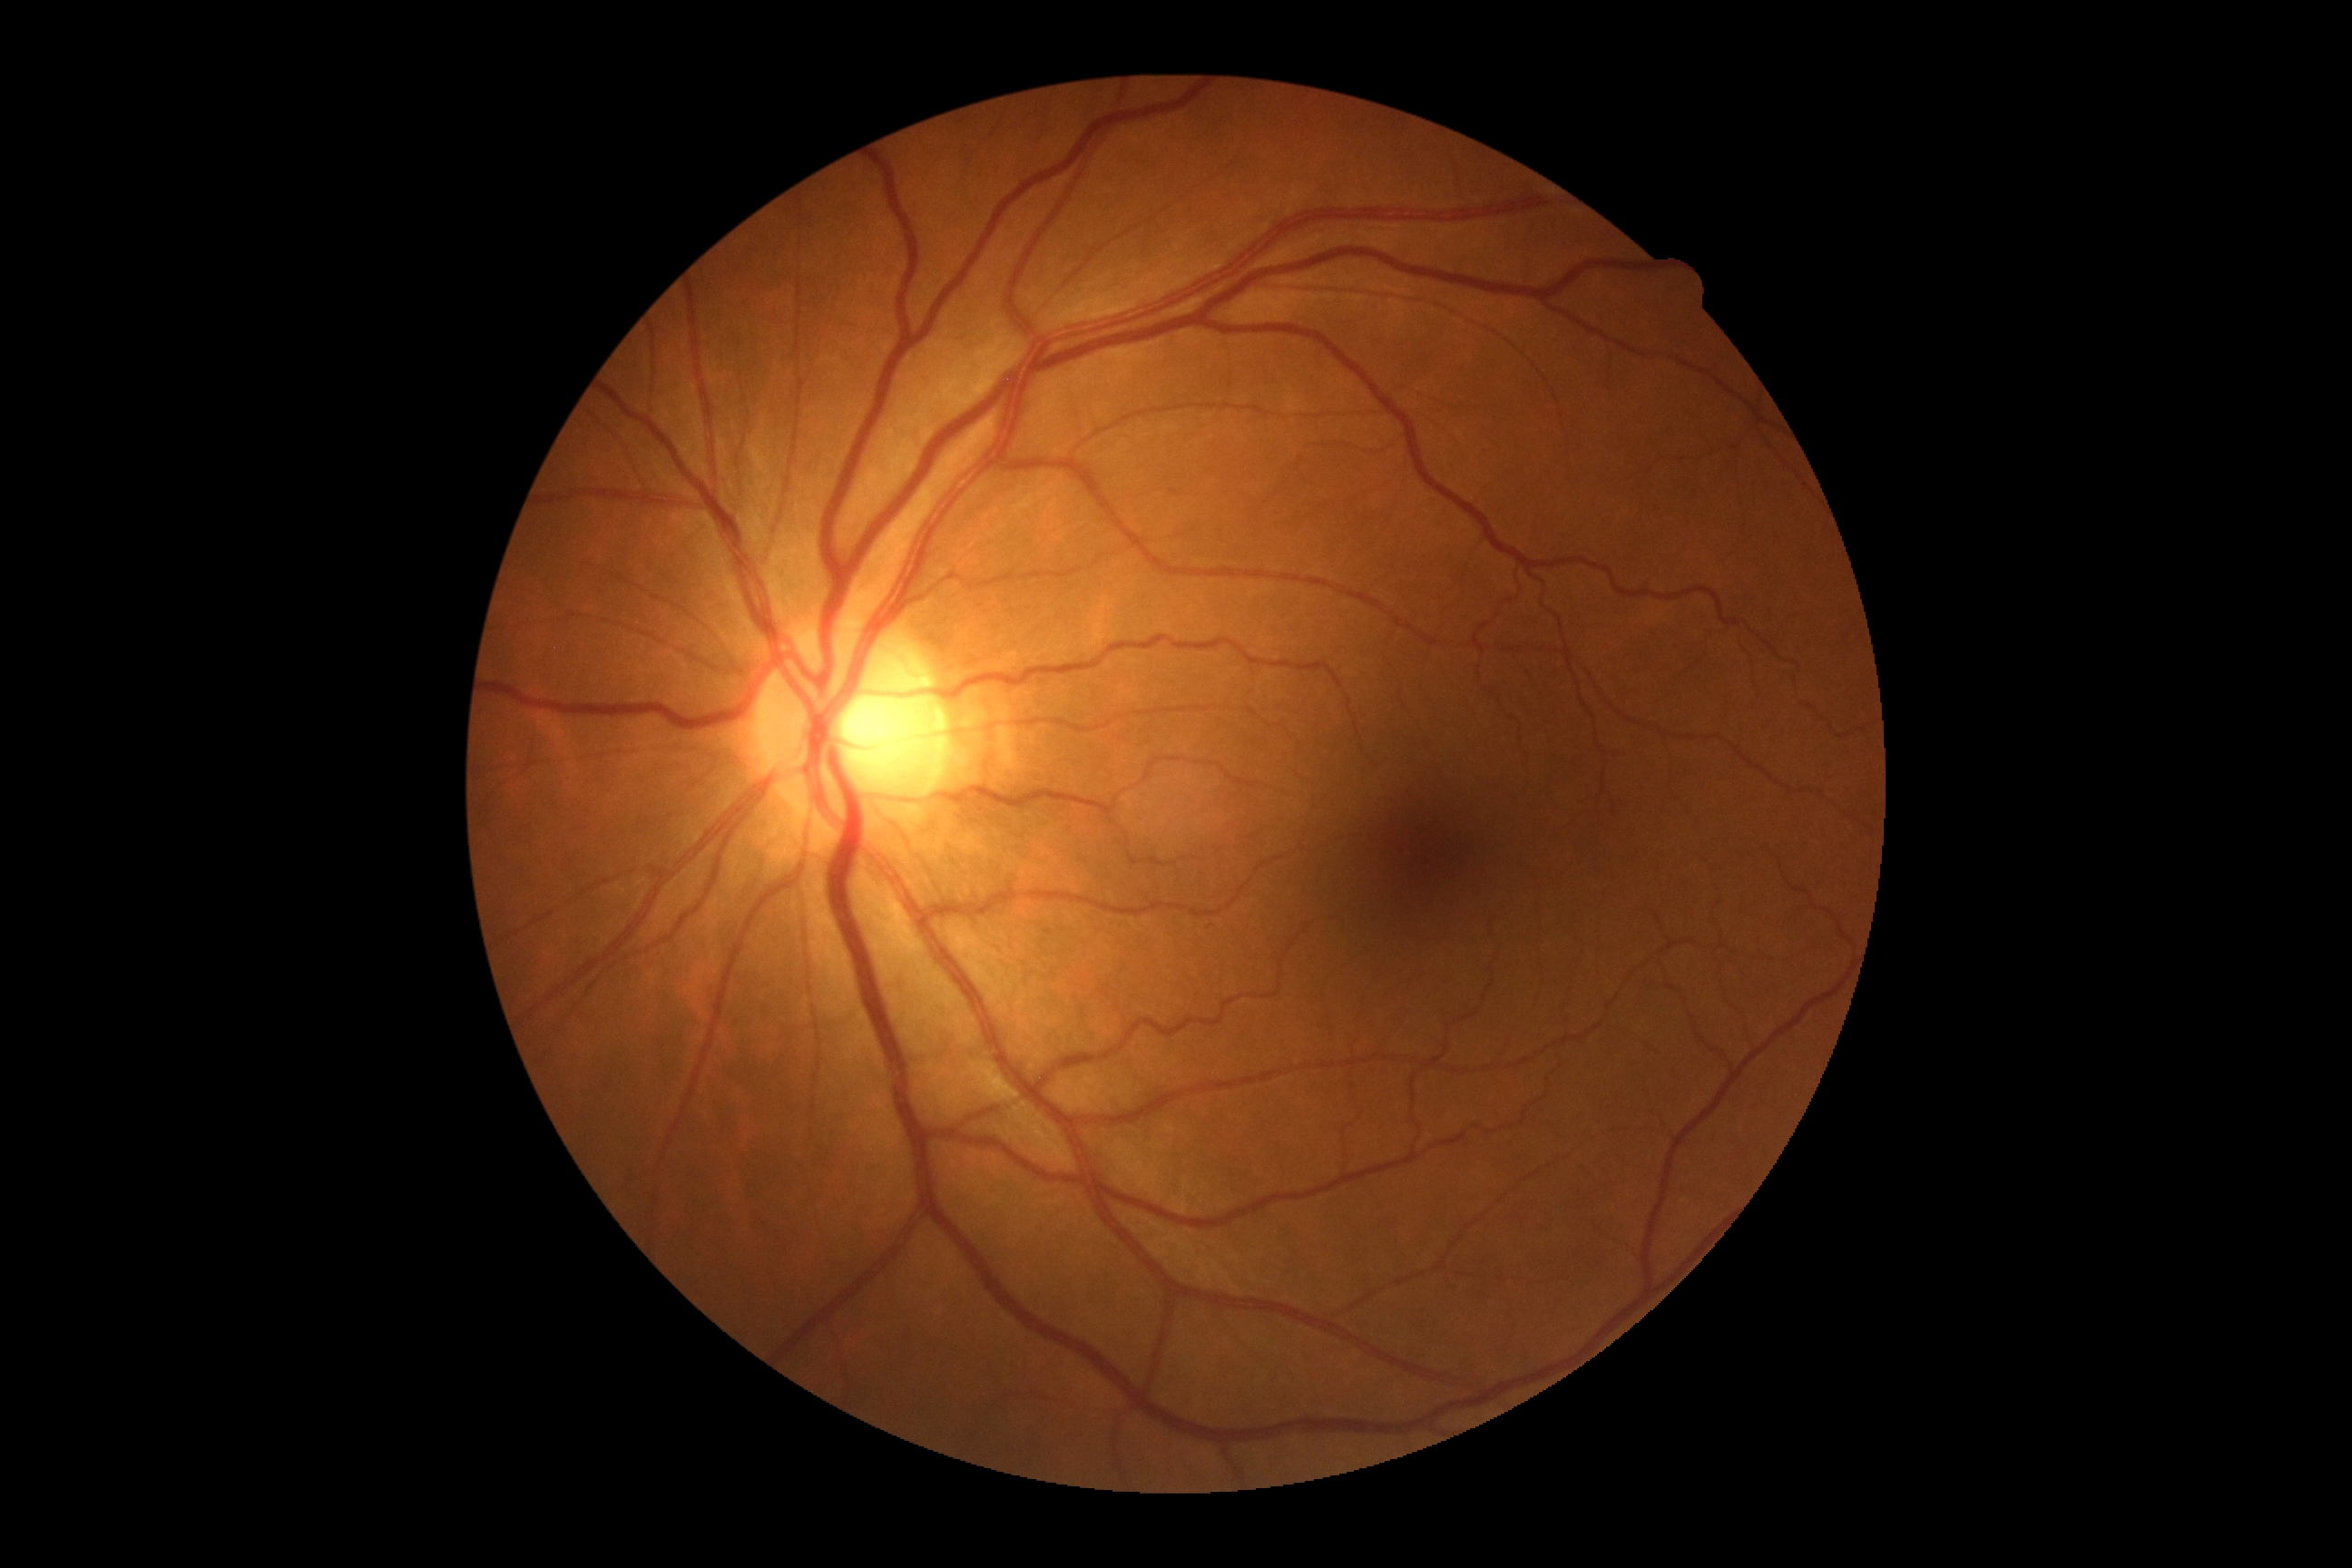 No apparent diabetic retinopathy. Diabetic retinopathy (DR) is 0/4.